Nonmydriatic — 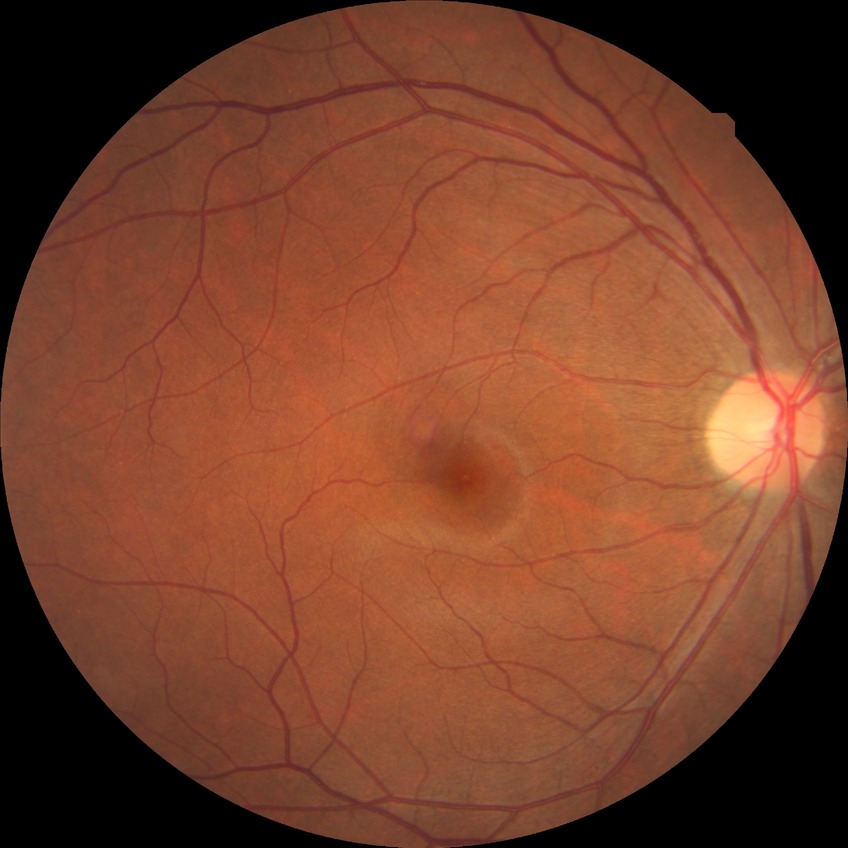
{
  "davis_grade": "SDR",
  "proliferative_class": "non-proliferative diabetic retinopathy"
}